Man; visual field mean deviation: -2.02 dB; autorefraction: +1 -0.75 x 125; age 76; intraocular pressure (IOP) (Perkins applanation tonometry): 24 mmHg:
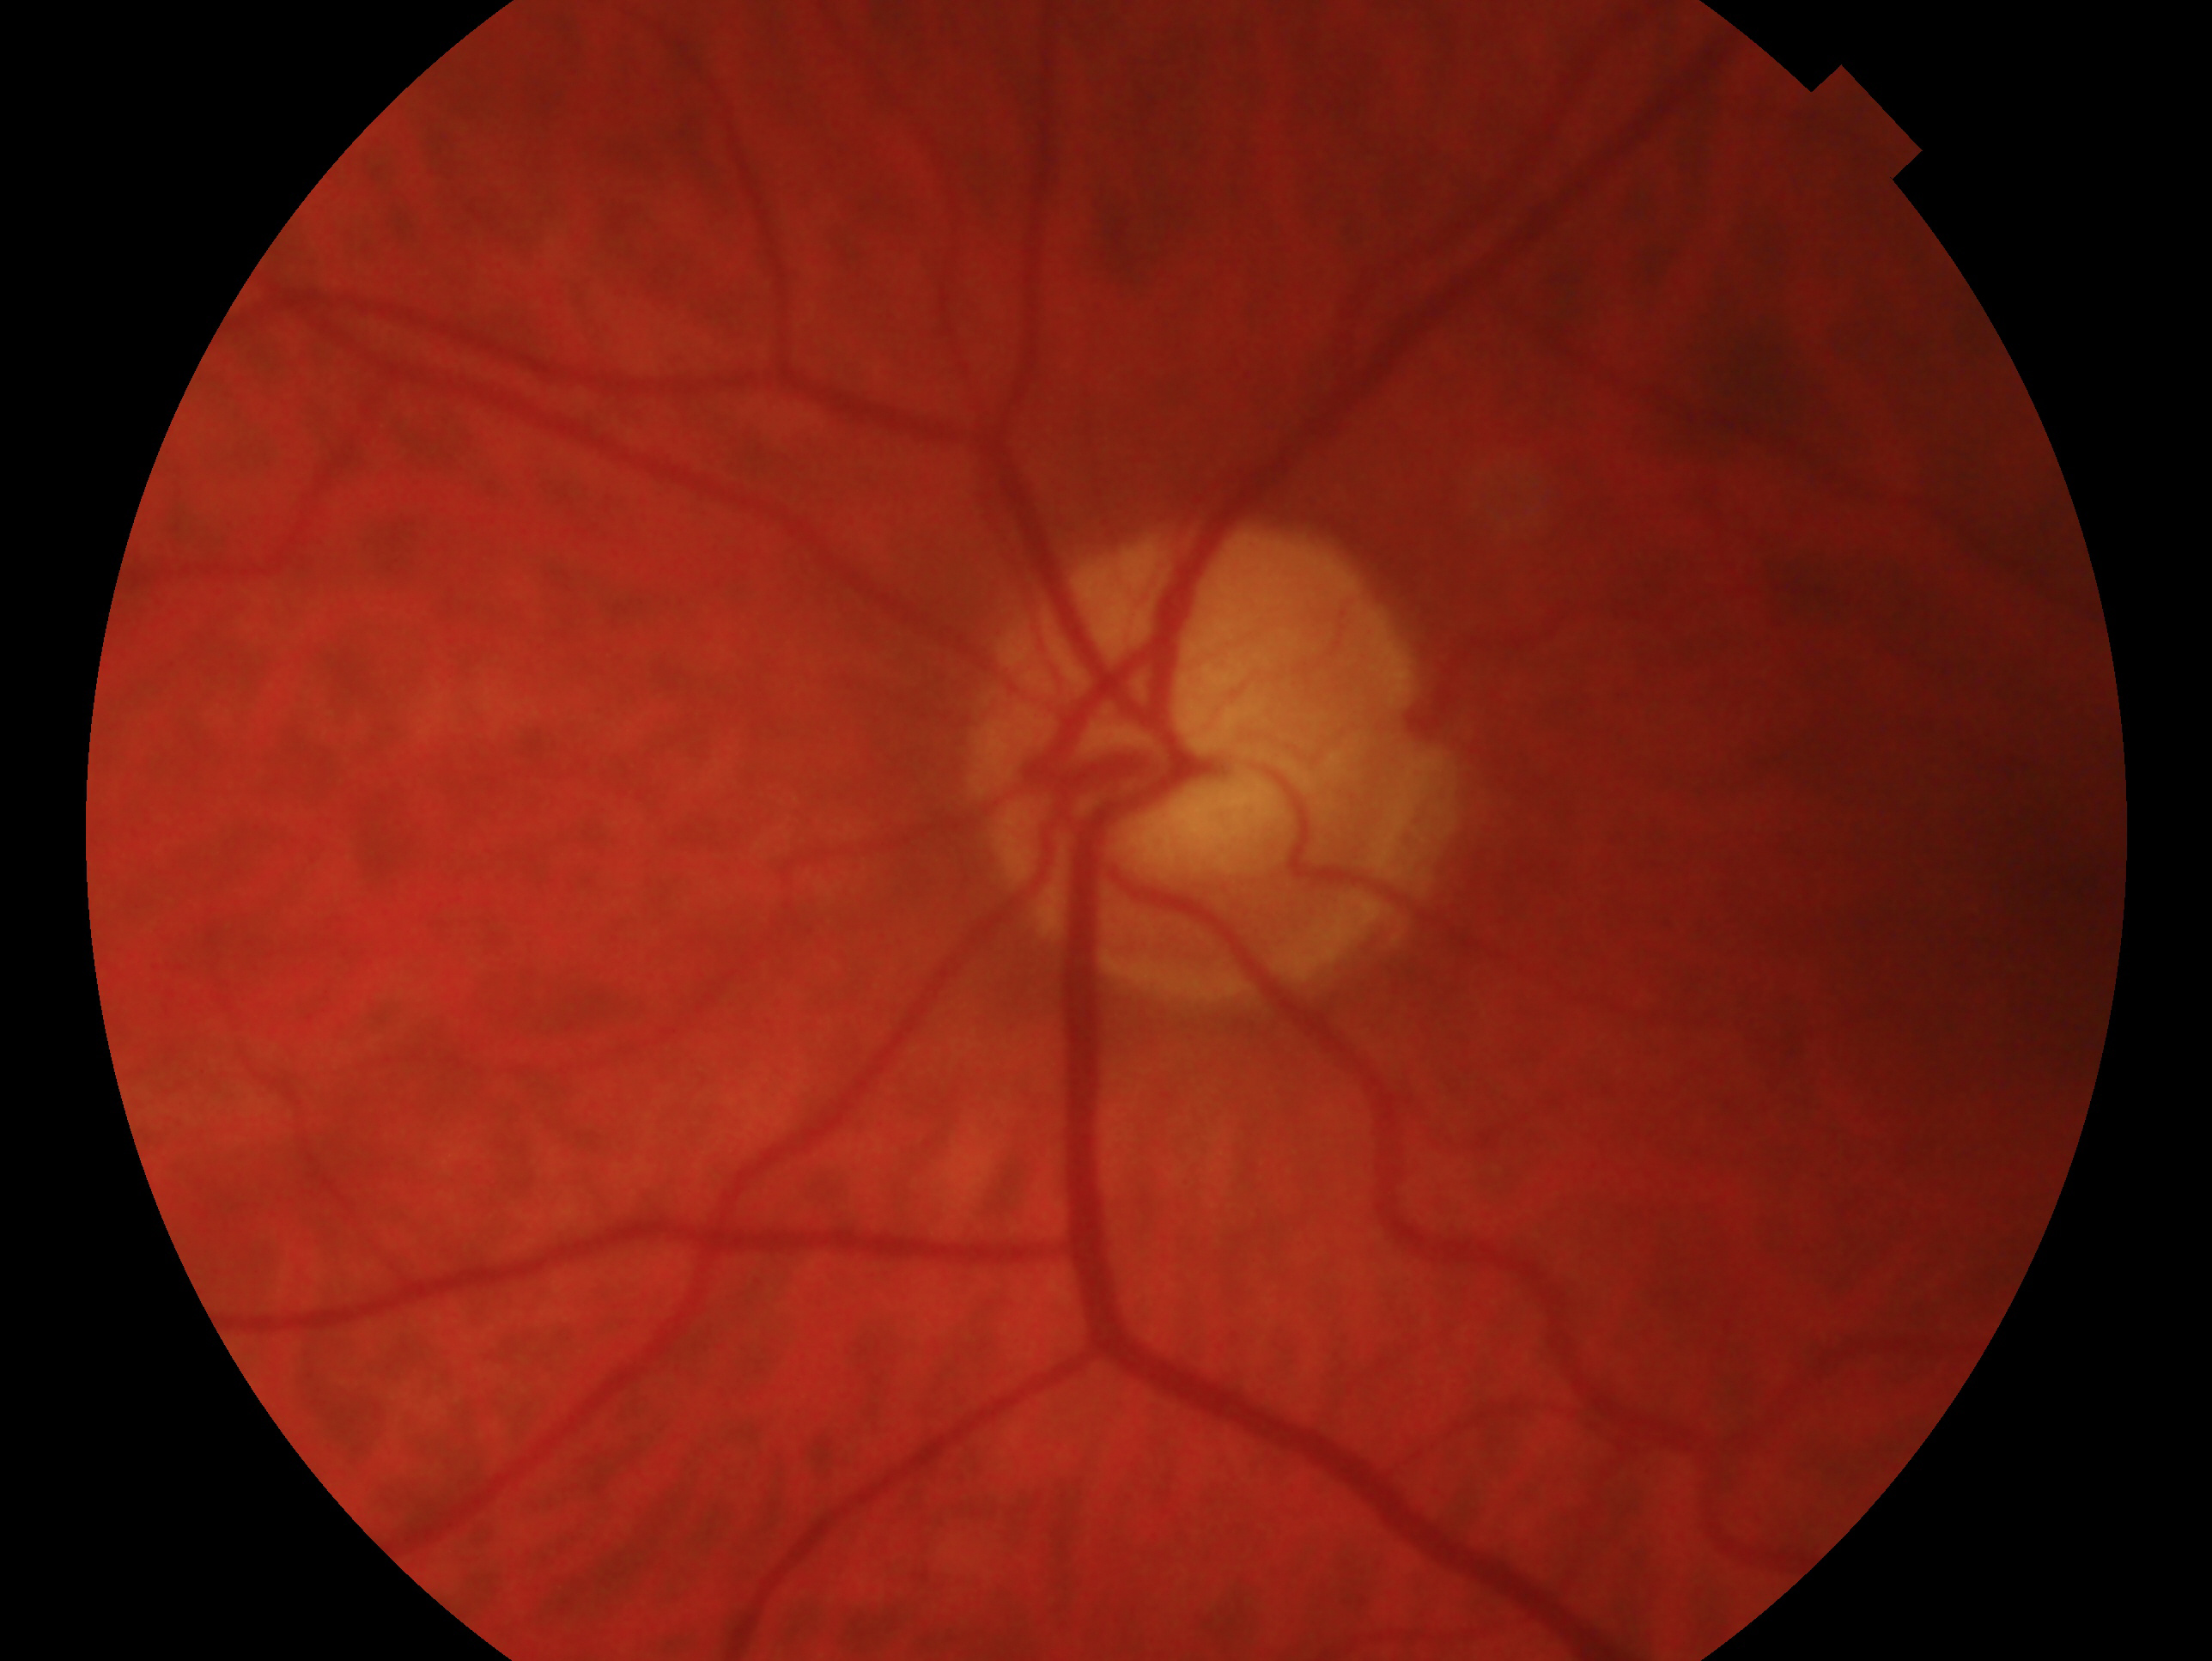
This is the left eye.
Glaucoma diagnosis — glaucoma.